Wide-field contact fundus photograph of an infant.
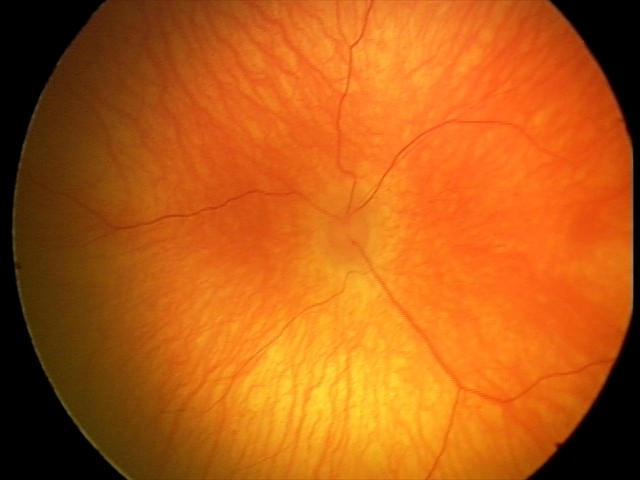

Impression: normal retinal appearance.